Dilated pupil, 337x337px, fundus photograph cropped around the optic nerve head.
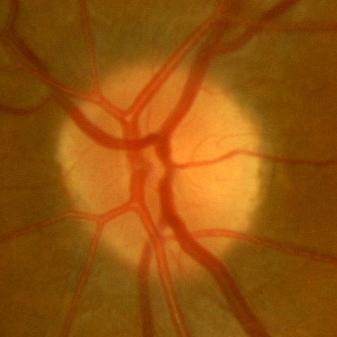

Showing no glaucomatous damage.